Graded on the modified Davis scale · 45 degree fundus photograph.
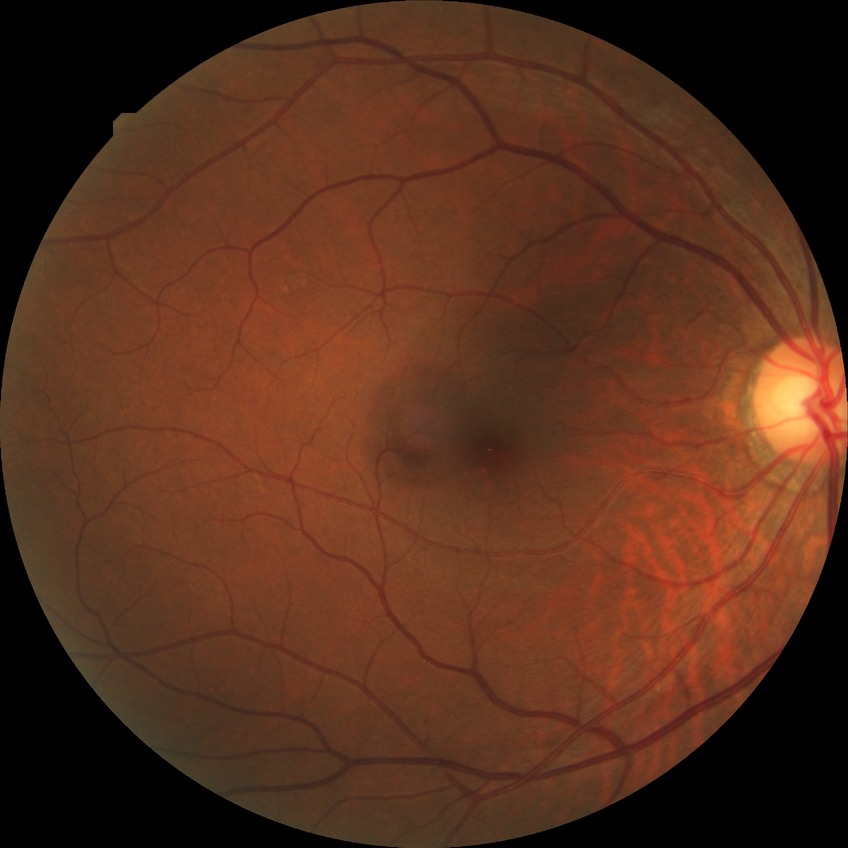 Diabetic retinopathy grade: no diabetic retinopathy.